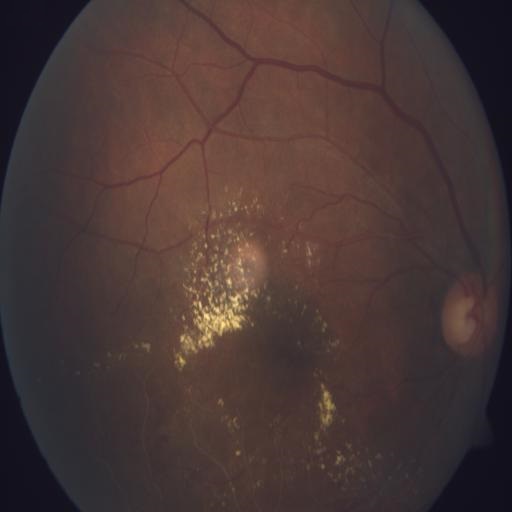 Diagnoses:
- exudation